Wide-field fundus image from infant ROP screening · 1240 x 1240 pixels · 100° field of view (Phoenix ICON)
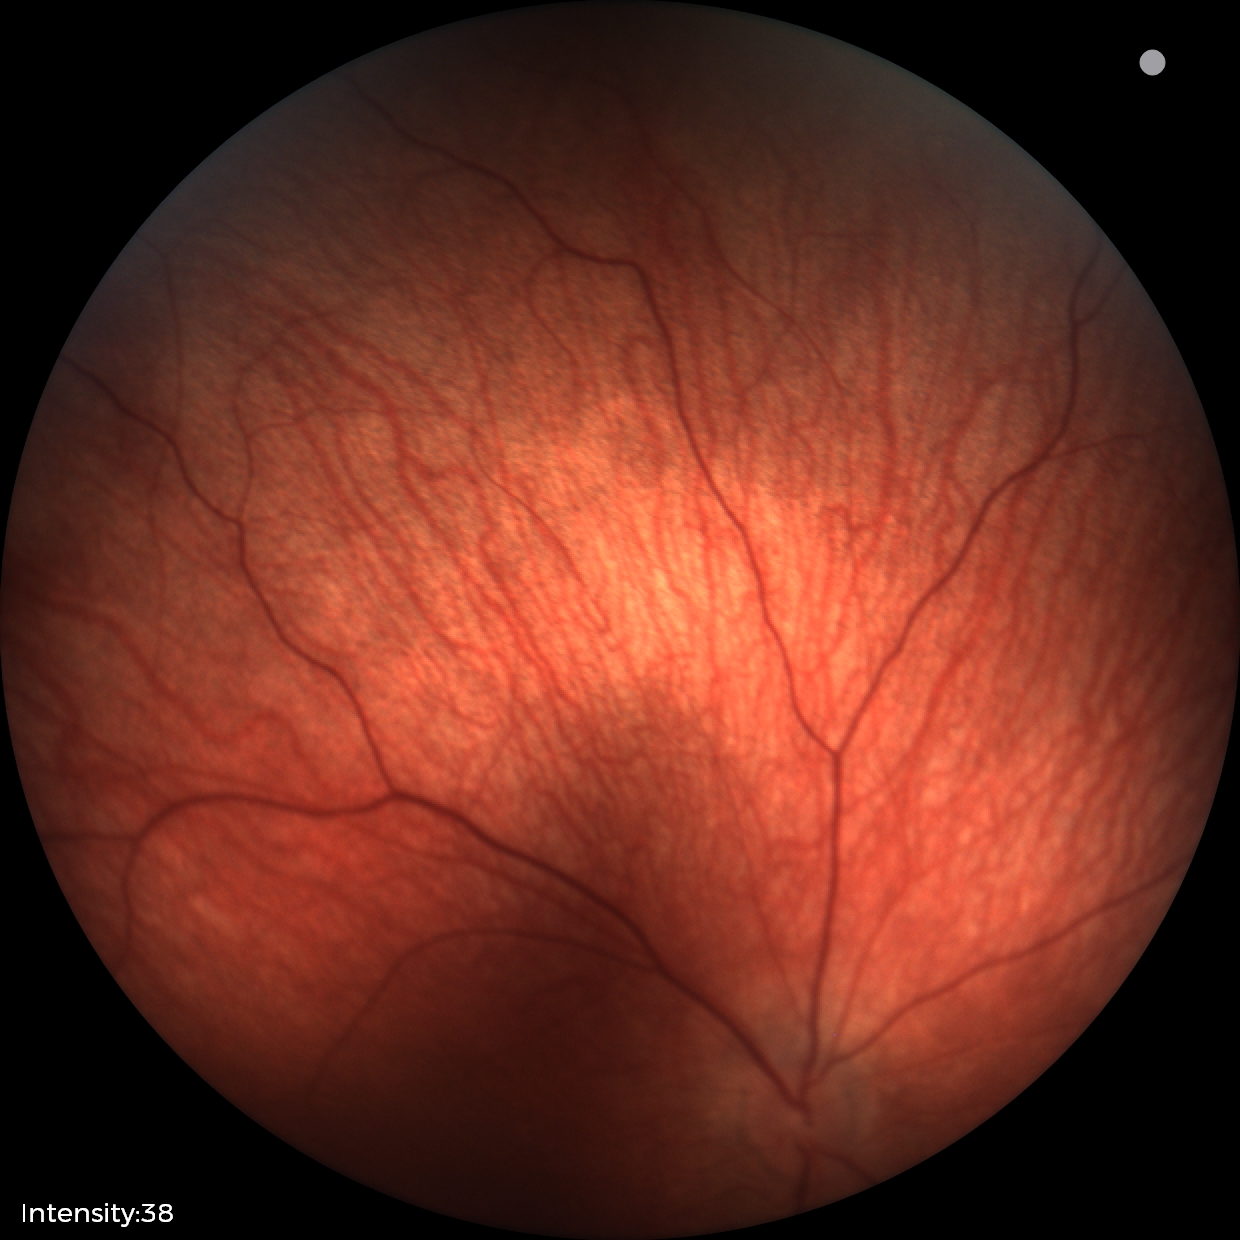 Screening examination with no abnormal retinal findings.